FOV: 45 degrees; color fundus image — 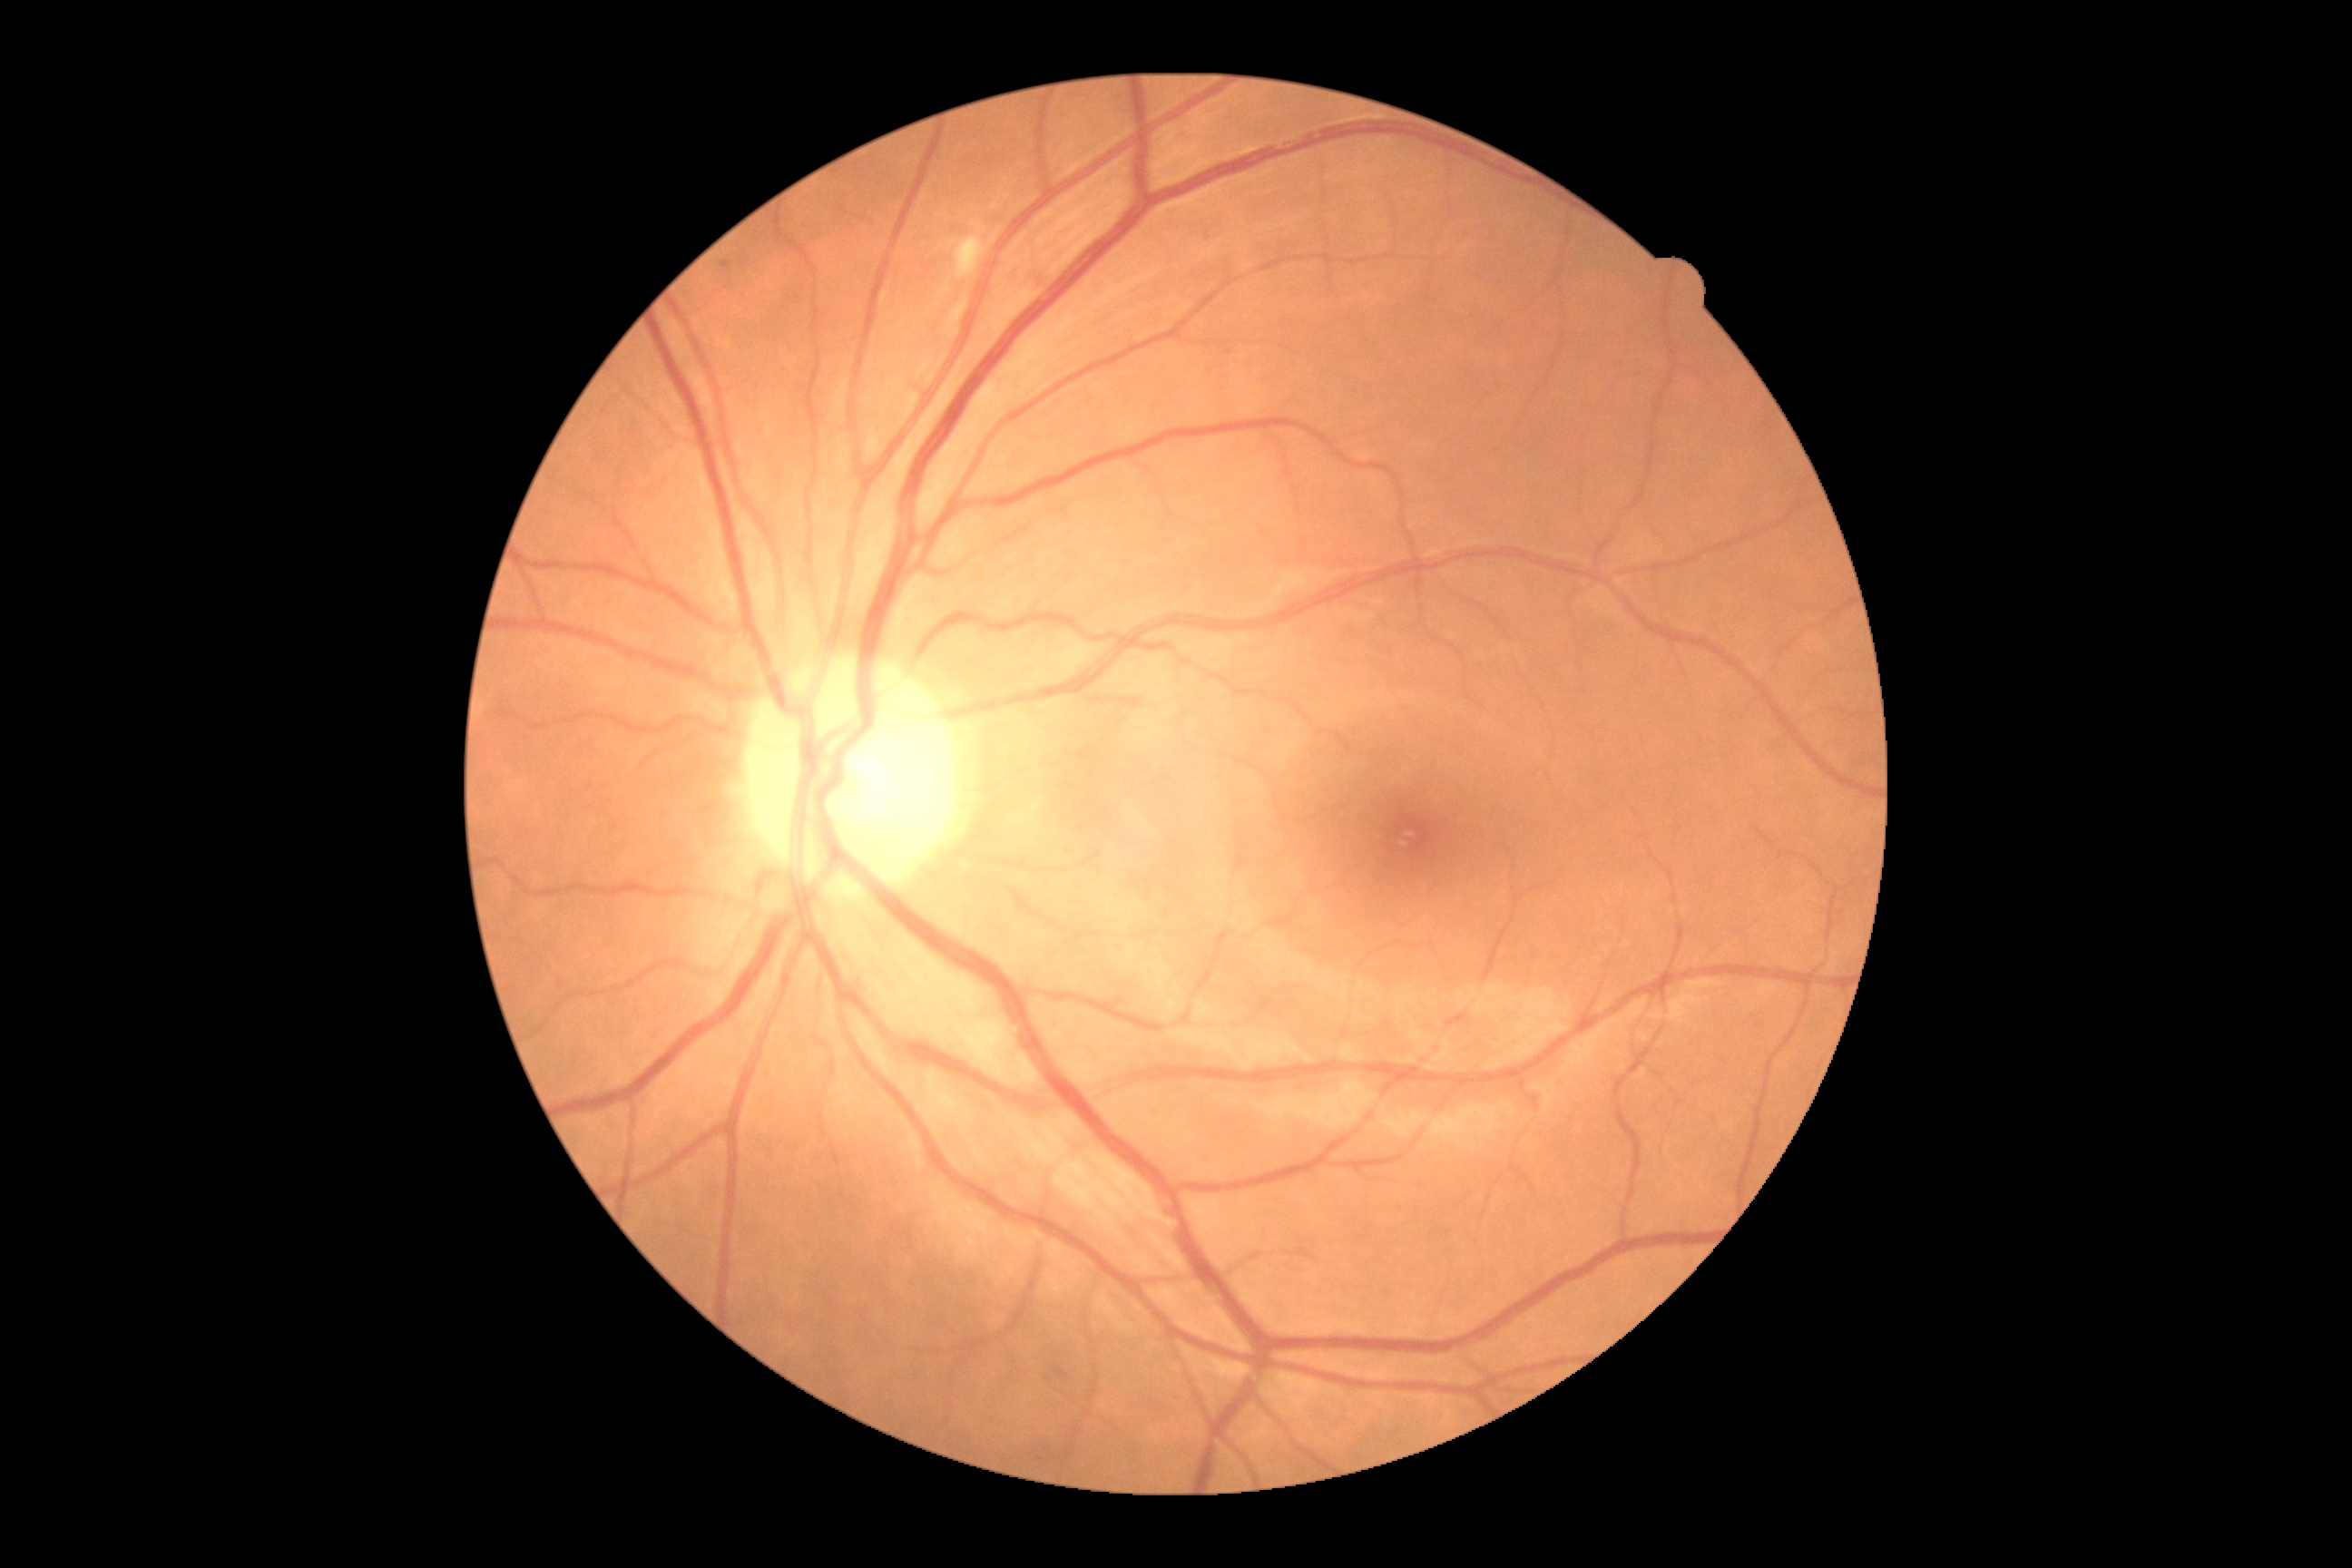
diabetic retinopathy (DR)=moderate NPDR (grade 2); DR class=non-proliferative diabetic retinopathy.